CFP; image size 2212x1659.
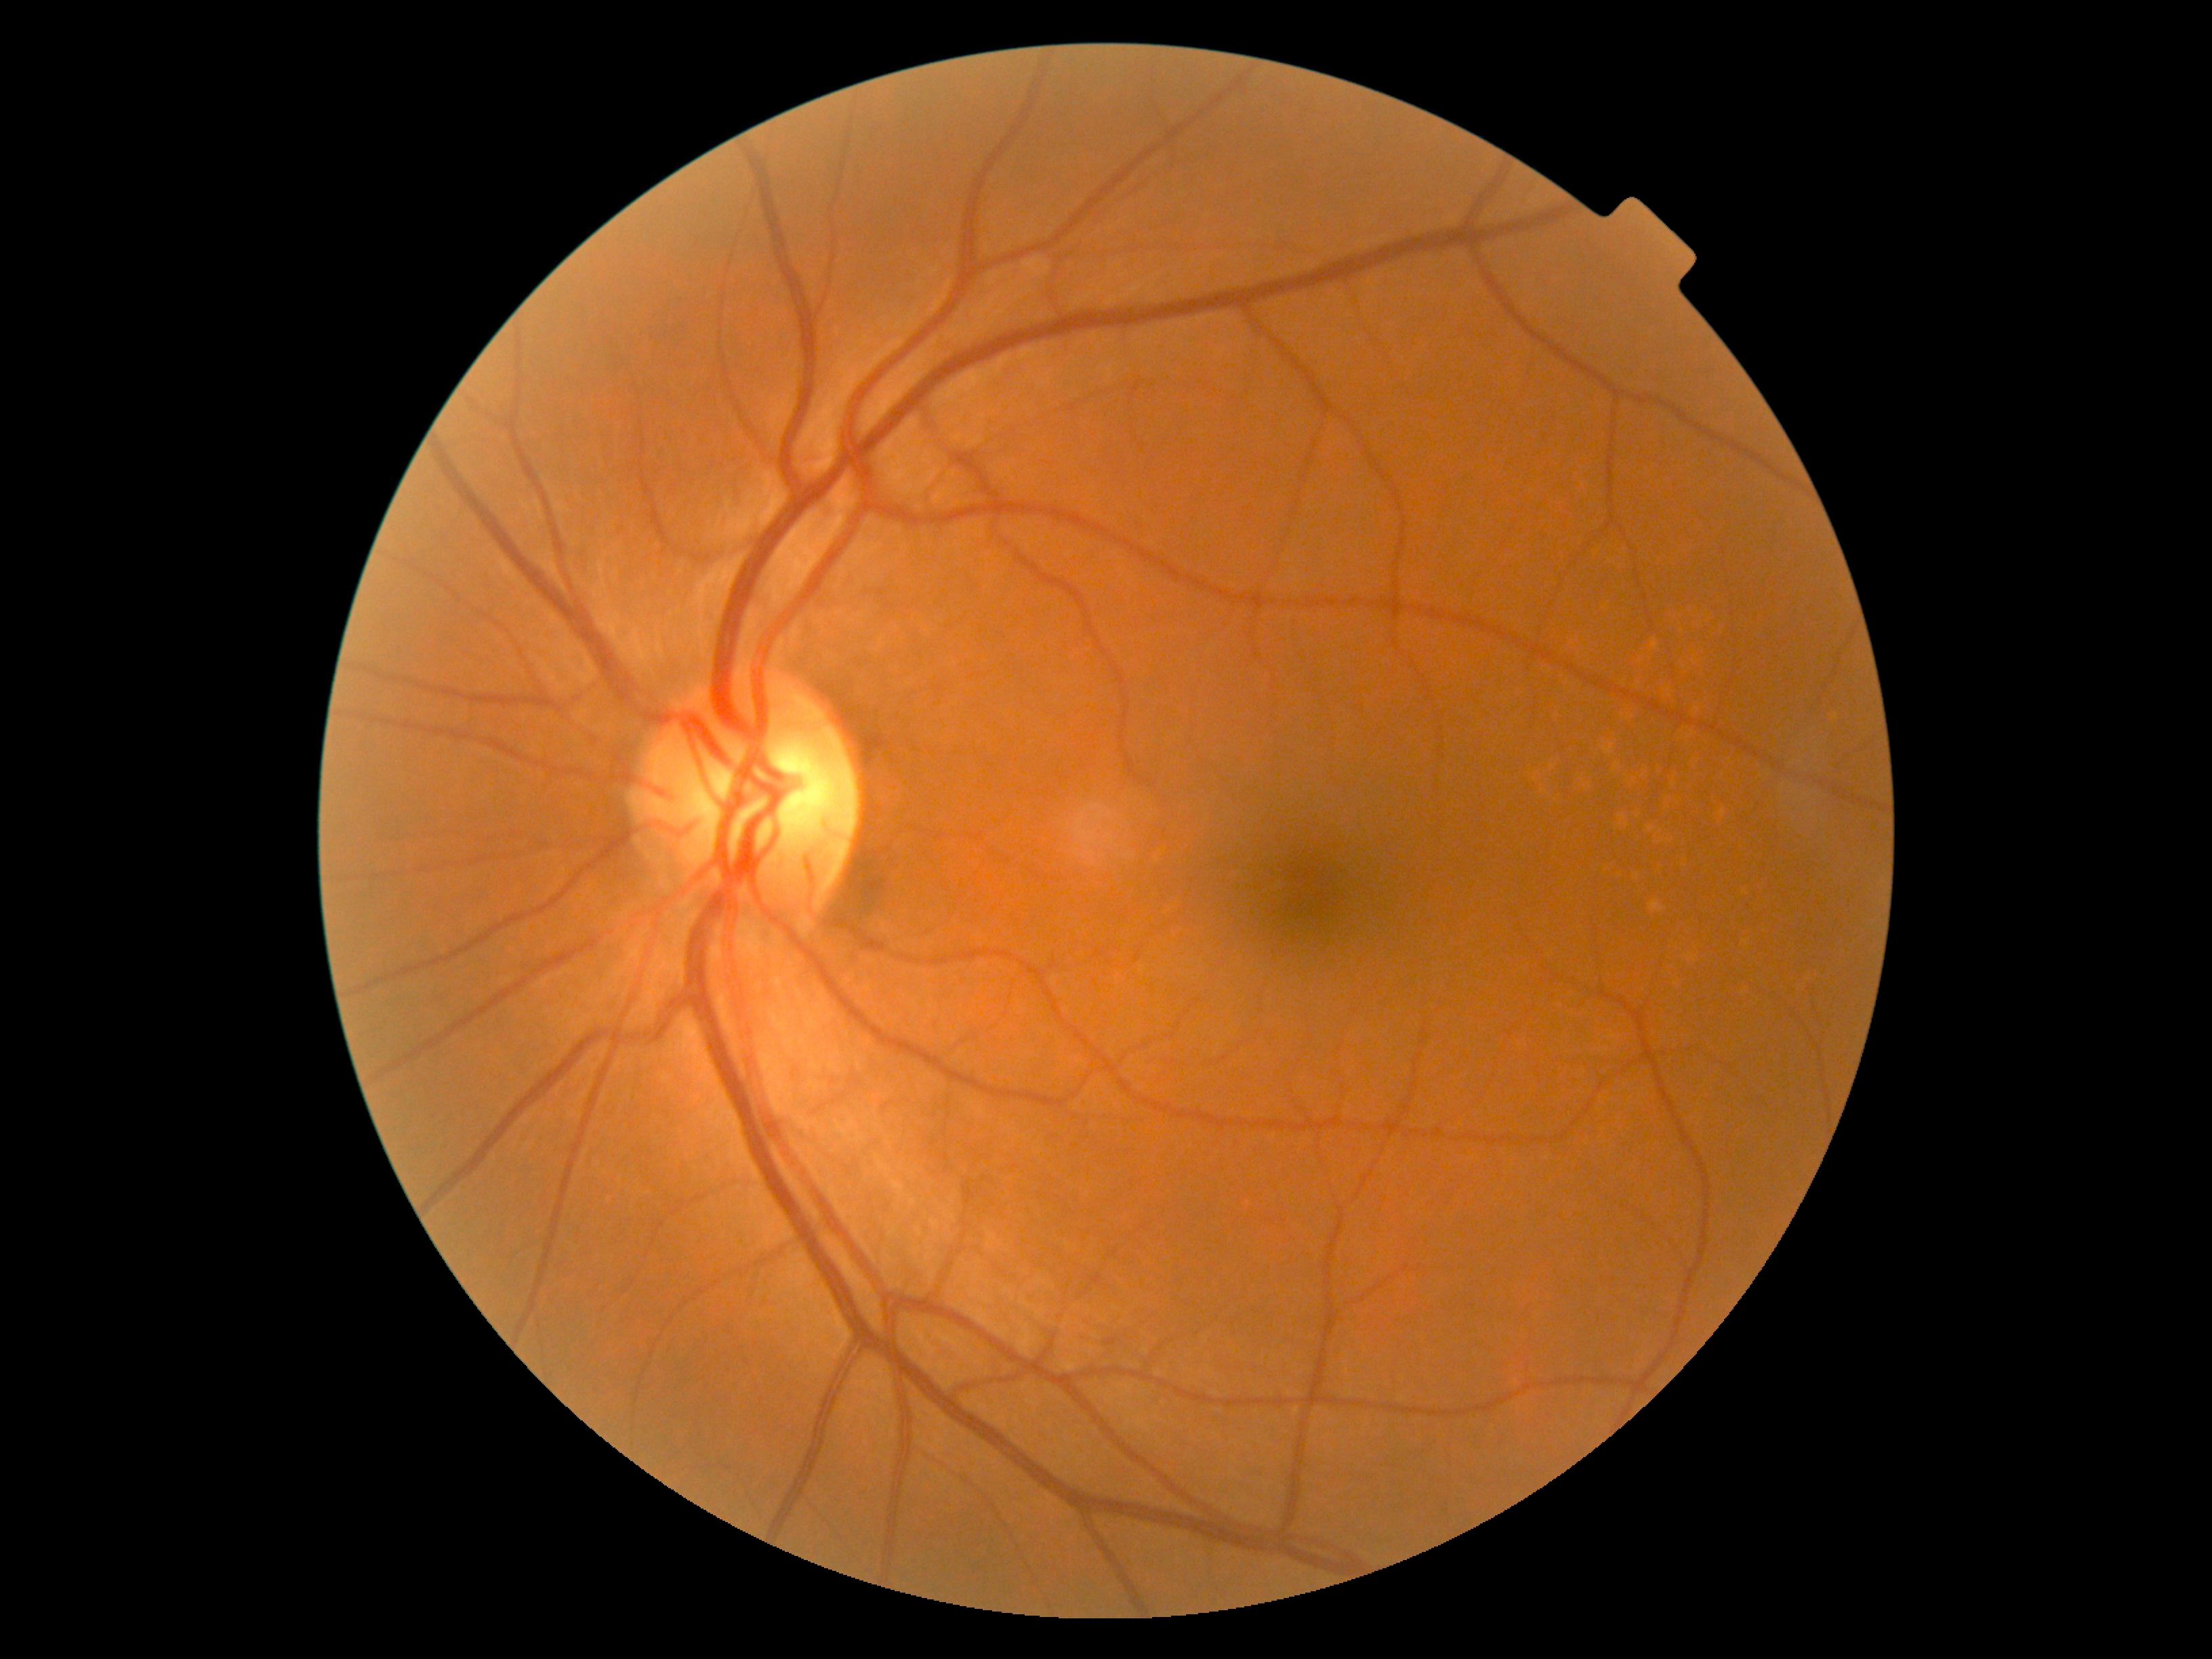 DR grade: 0 (no apparent retinopathy).